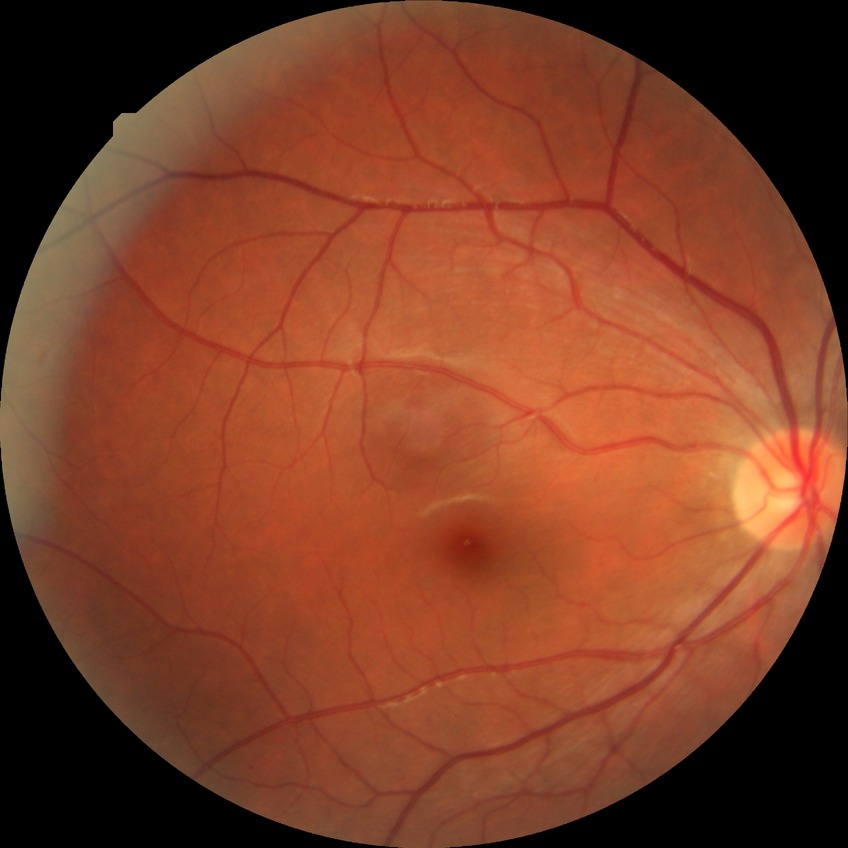
Diabetic retinopathy (DR): NDR (no diabetic retinopathy).